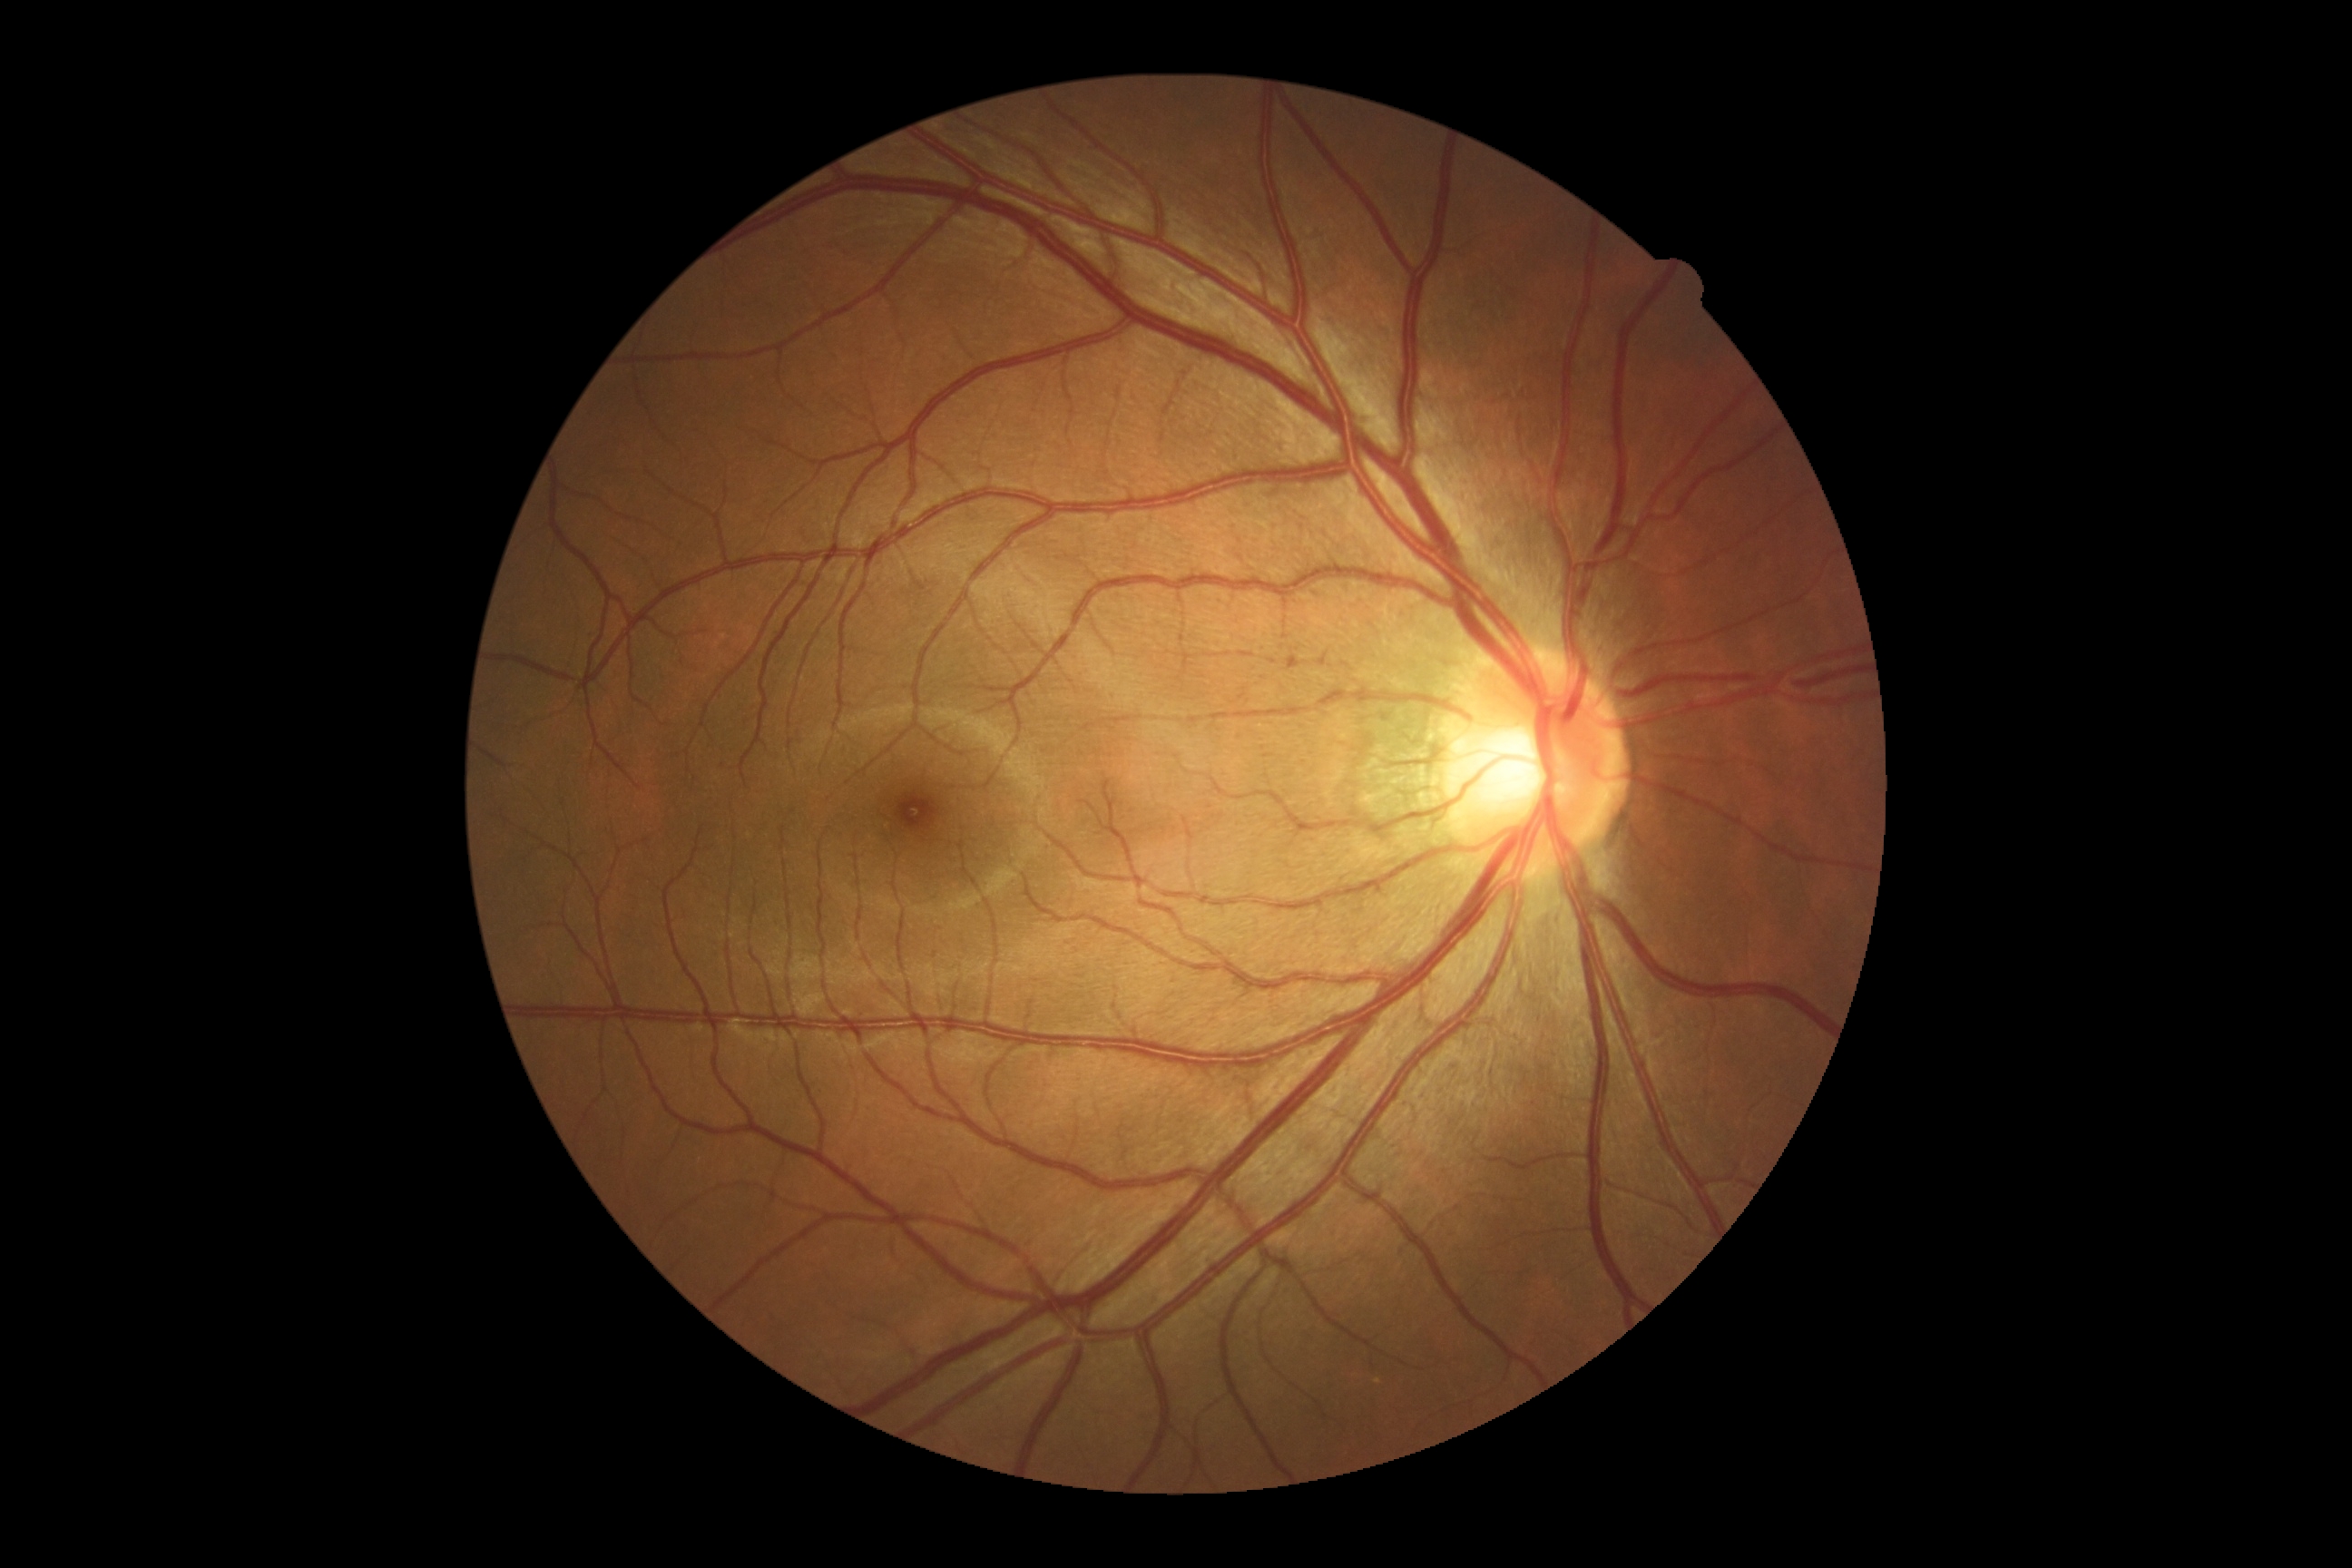 diabetic retinopathy grade@0 (no apparent retinopathy).